2228 x 1652 pixels: 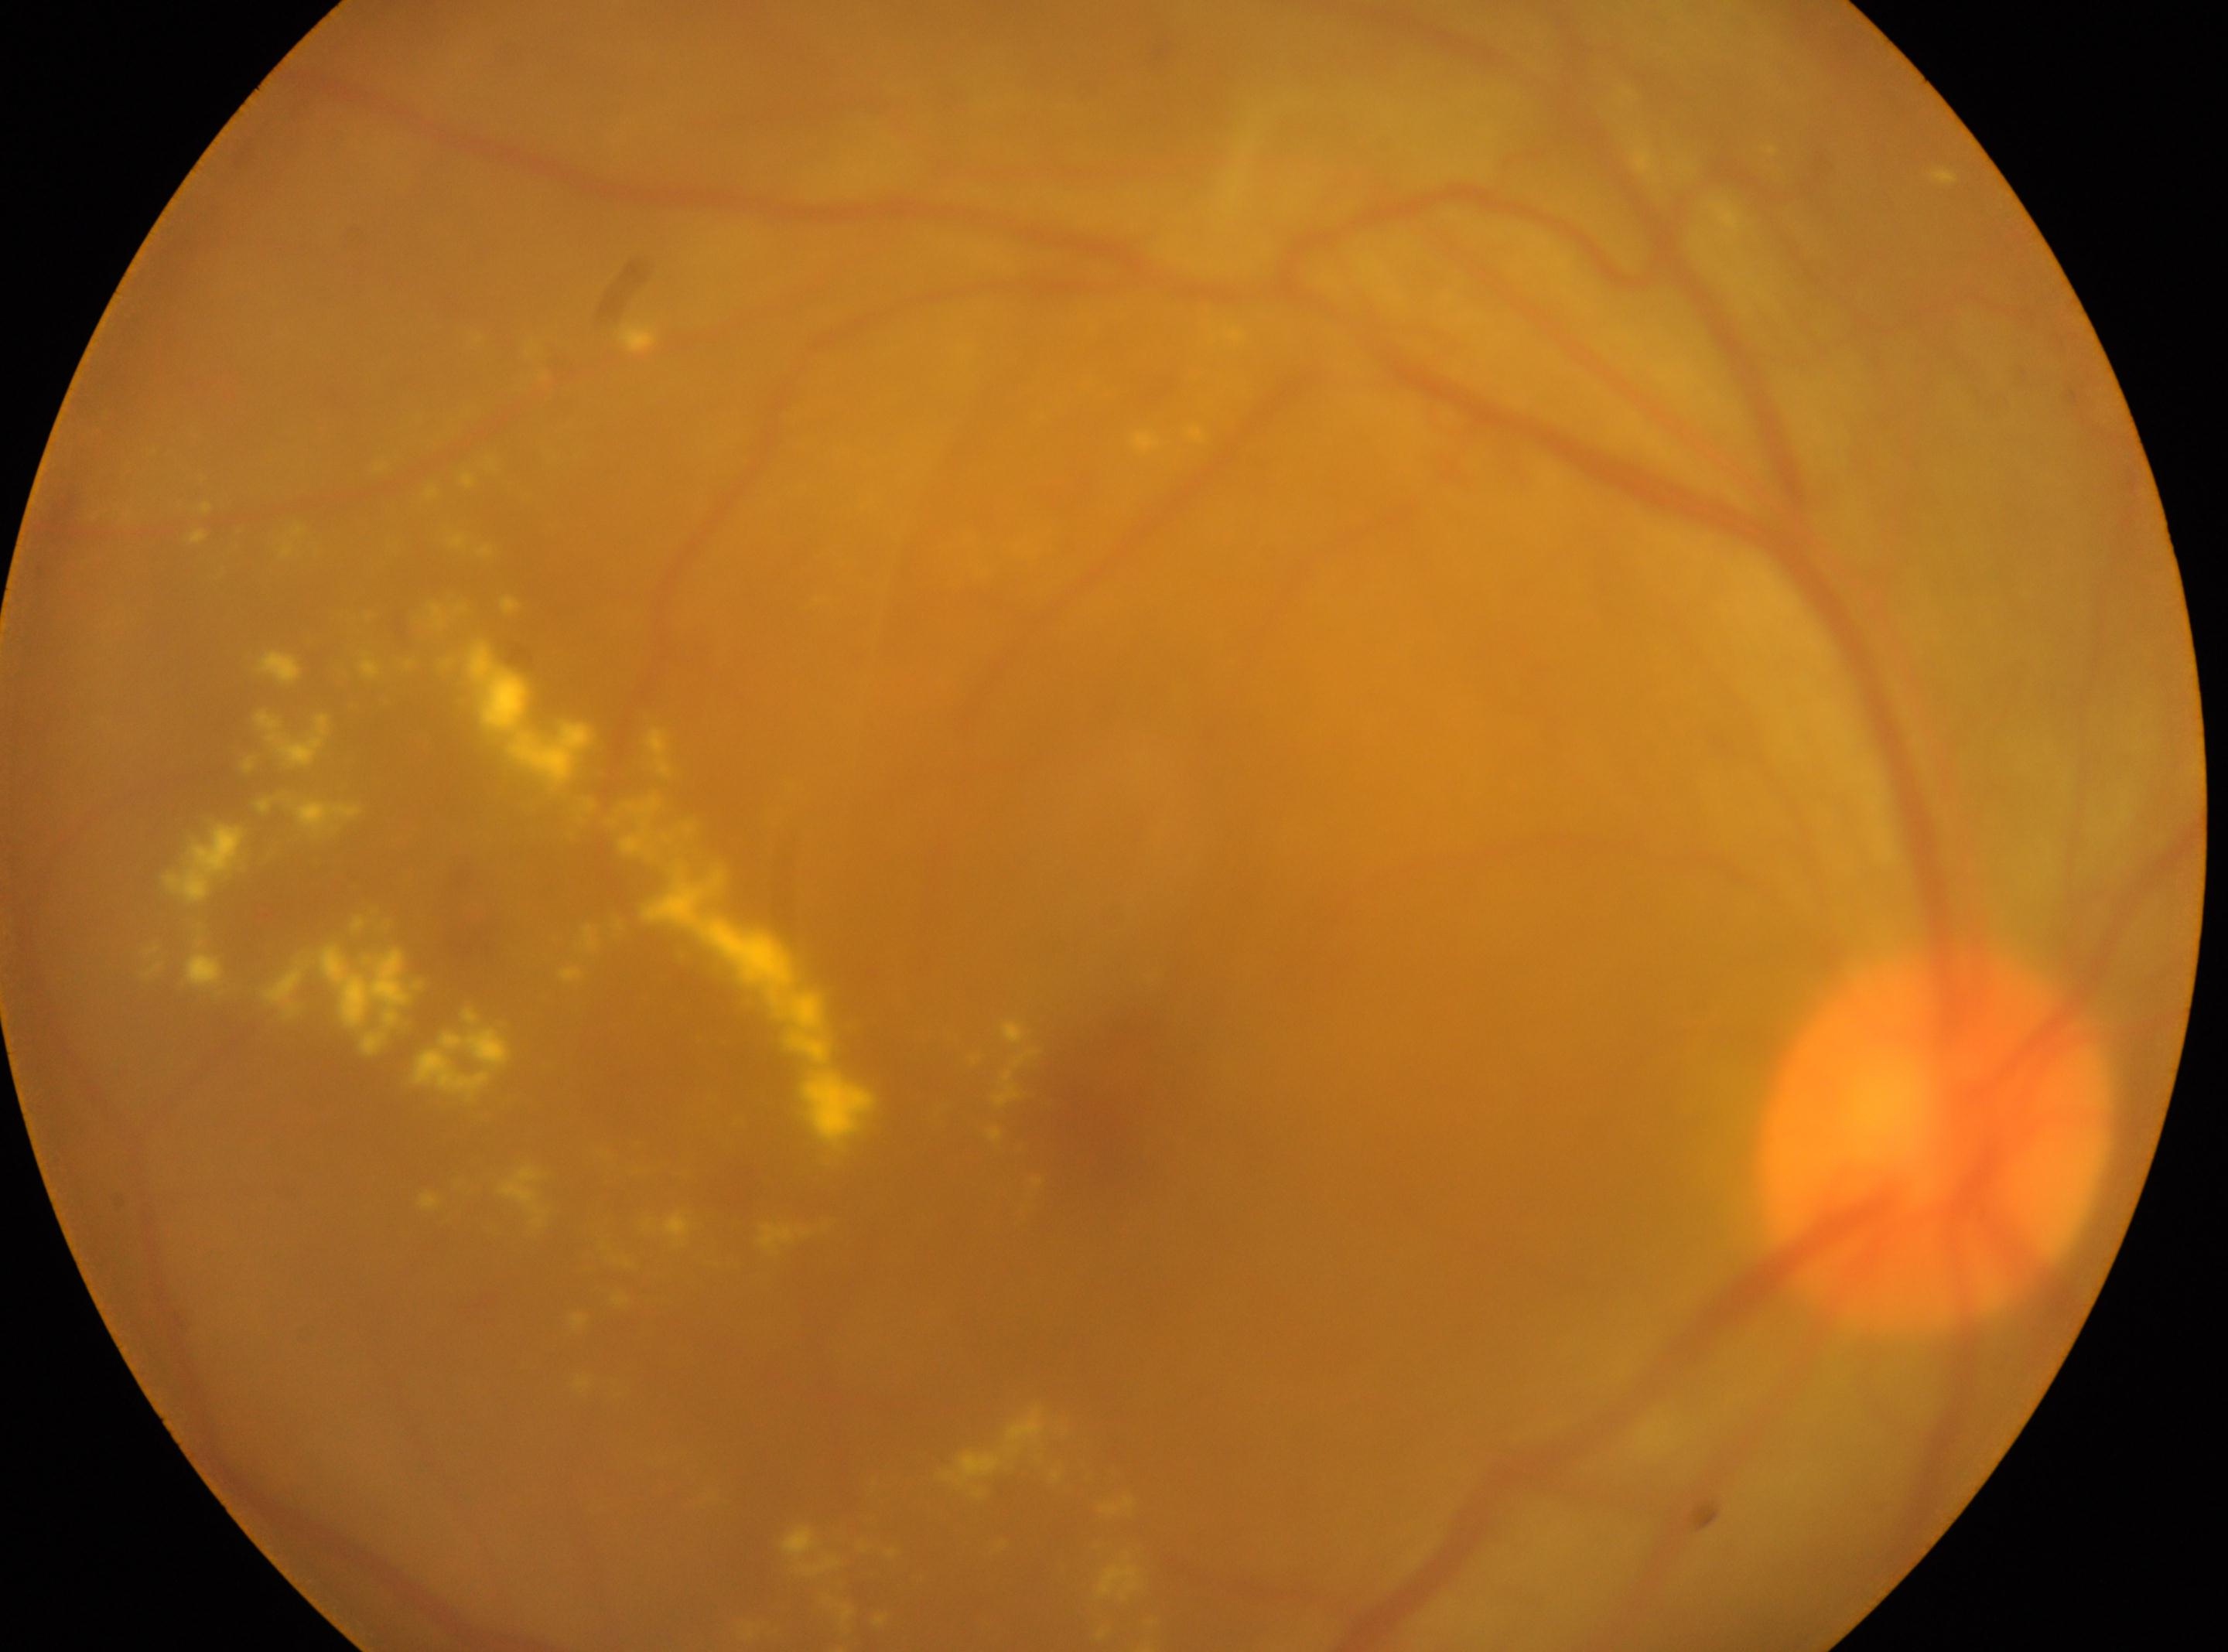

The fovea is at (x: 1091, y: 1121). The image shows the OD. The retinopathy is classified as proliferative diabetic retinopathy. Disc center located at (x: 1932, y: 1141). DR: PDR (grade 4).